Image size 2212x1659. 45-degree field of view — 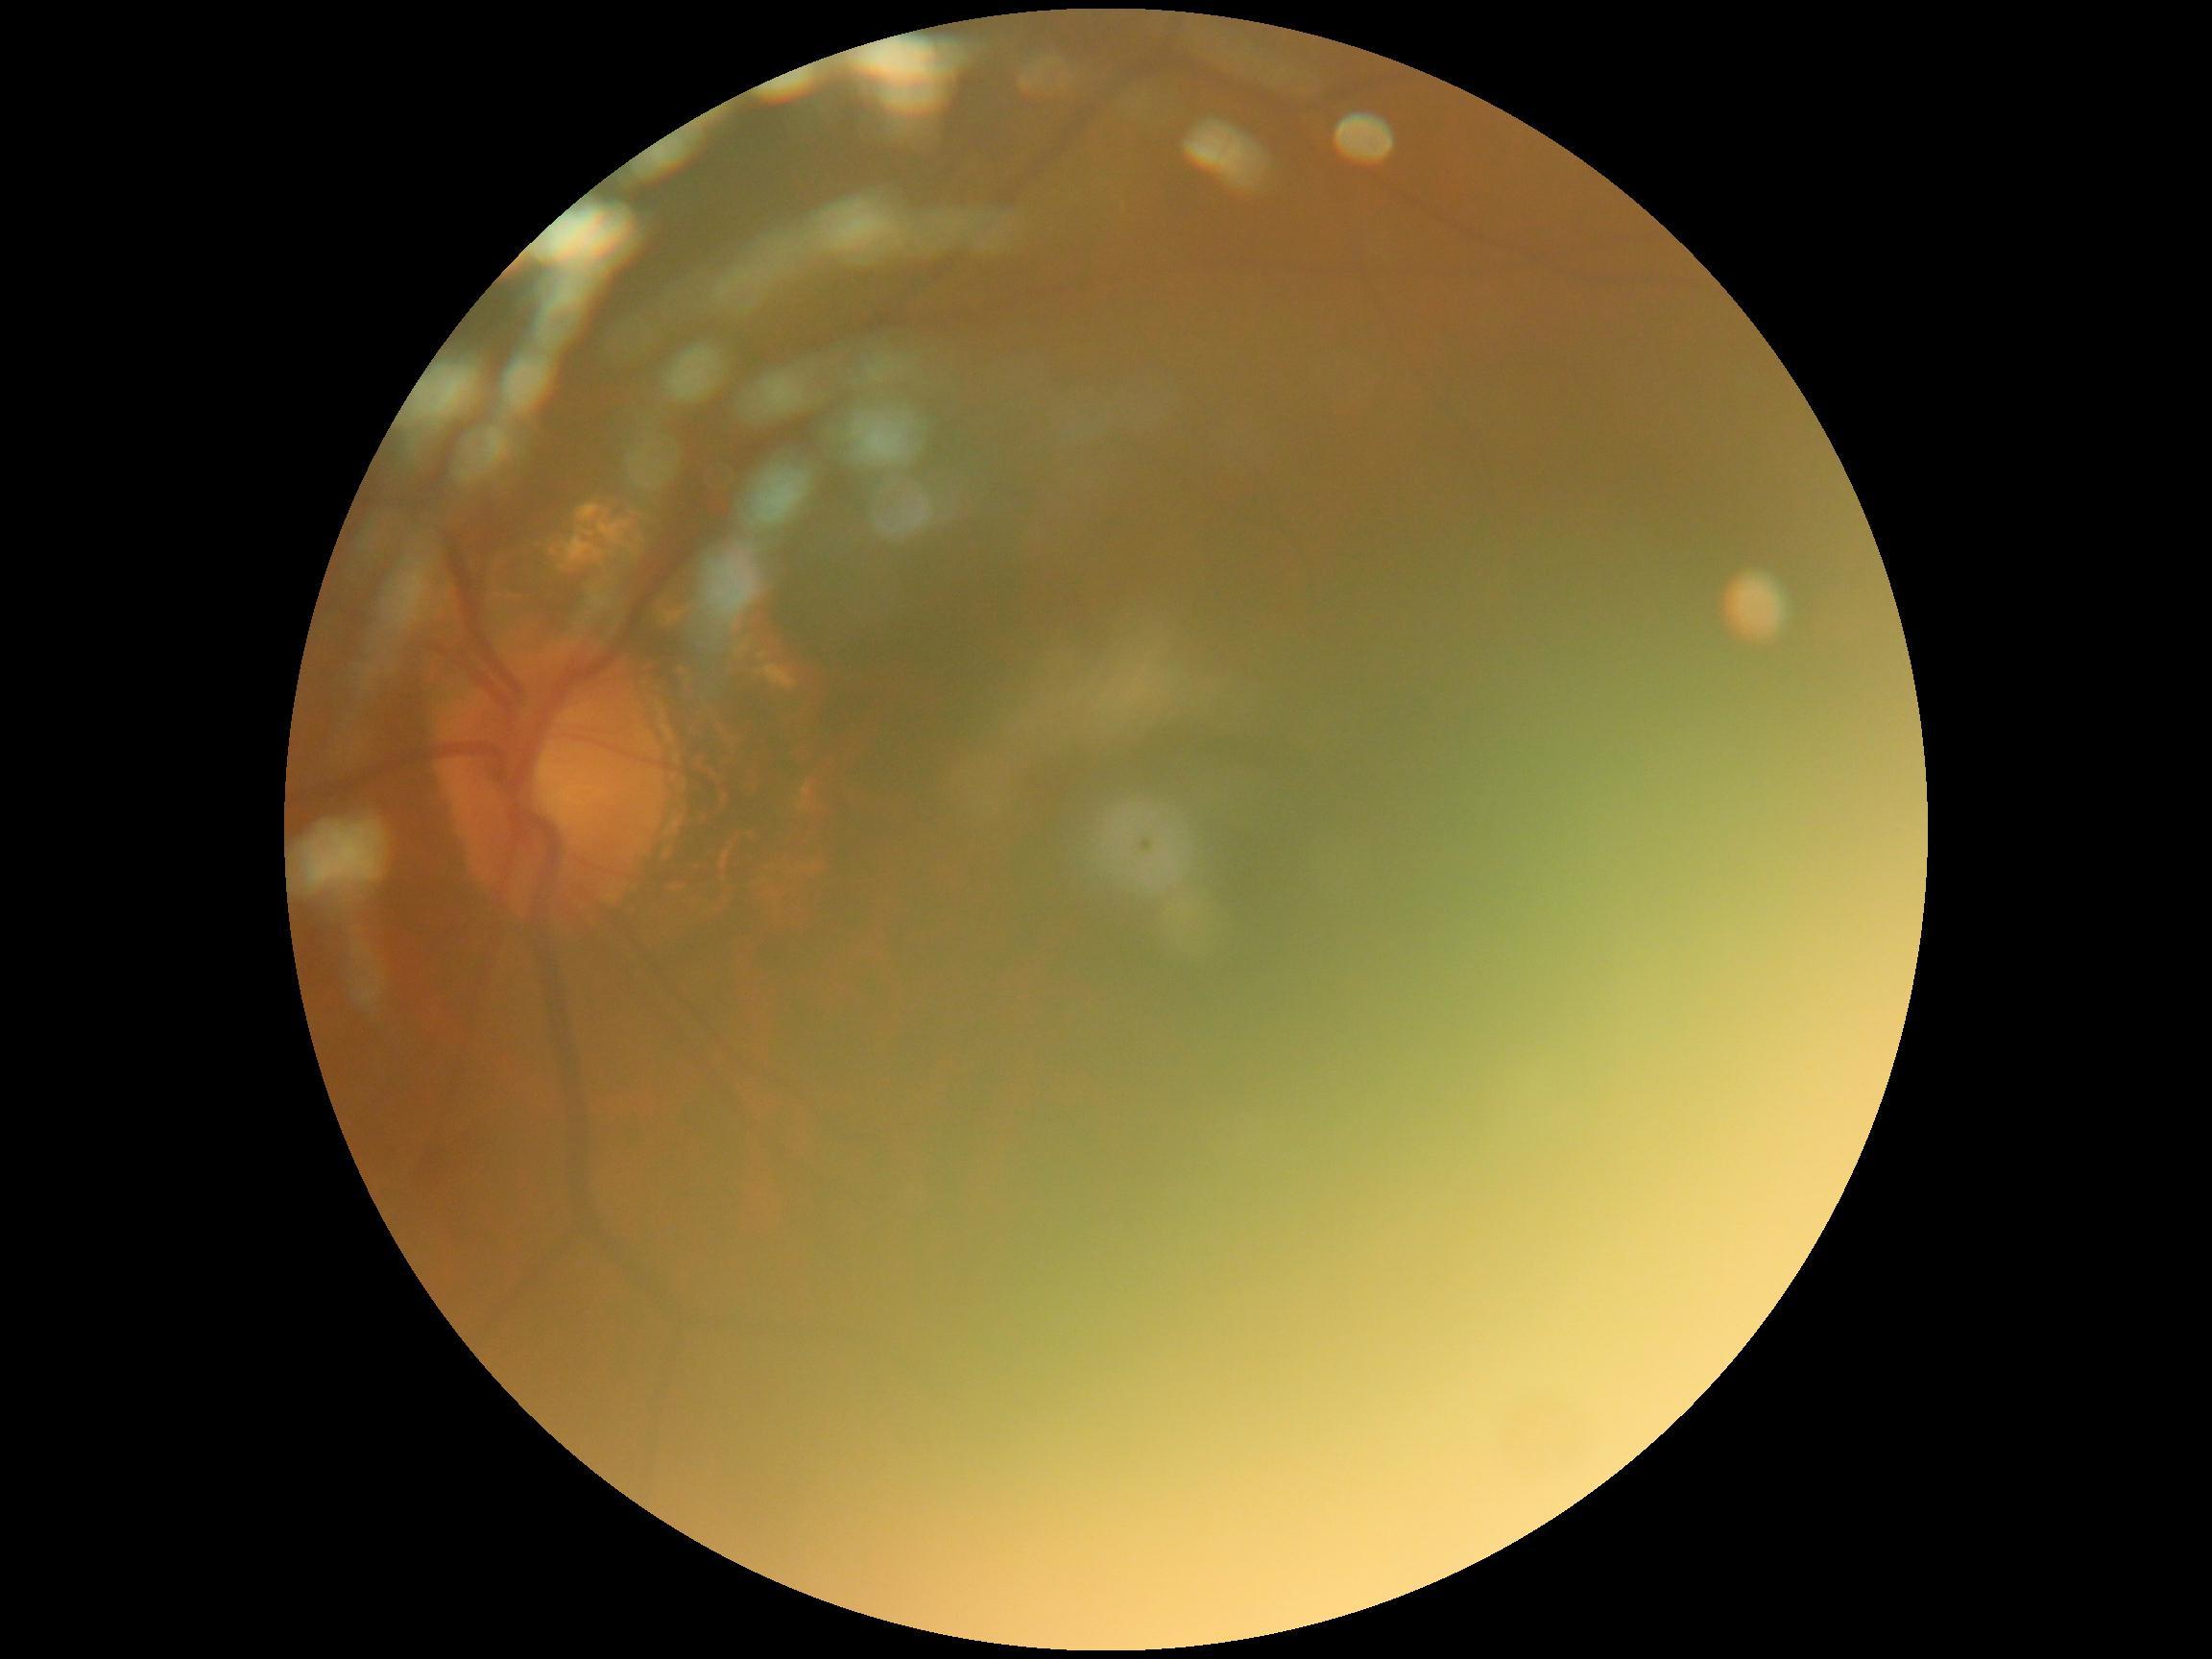
image quality = below grading threshold | DR severity = ungradable.